NIDEK AFC-230 fundus camera
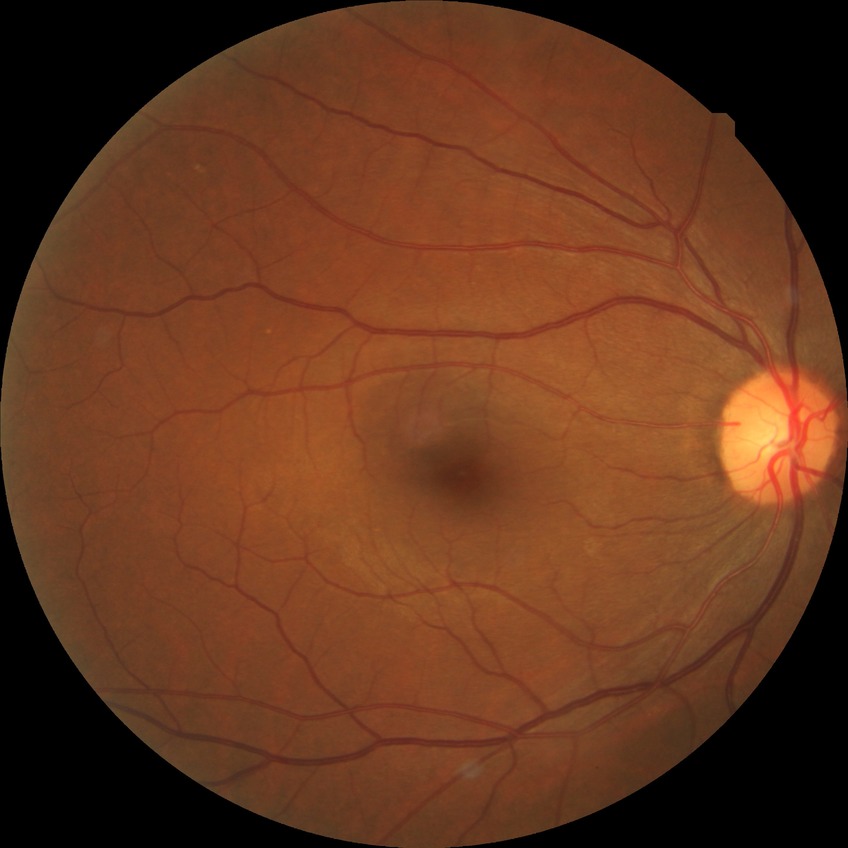

Diabetic retinopathy (DR): NDR (no diabetic retinopathy).